Phoenix ICON, 100° FOV. Pediatric retinal photograph (wide-field).
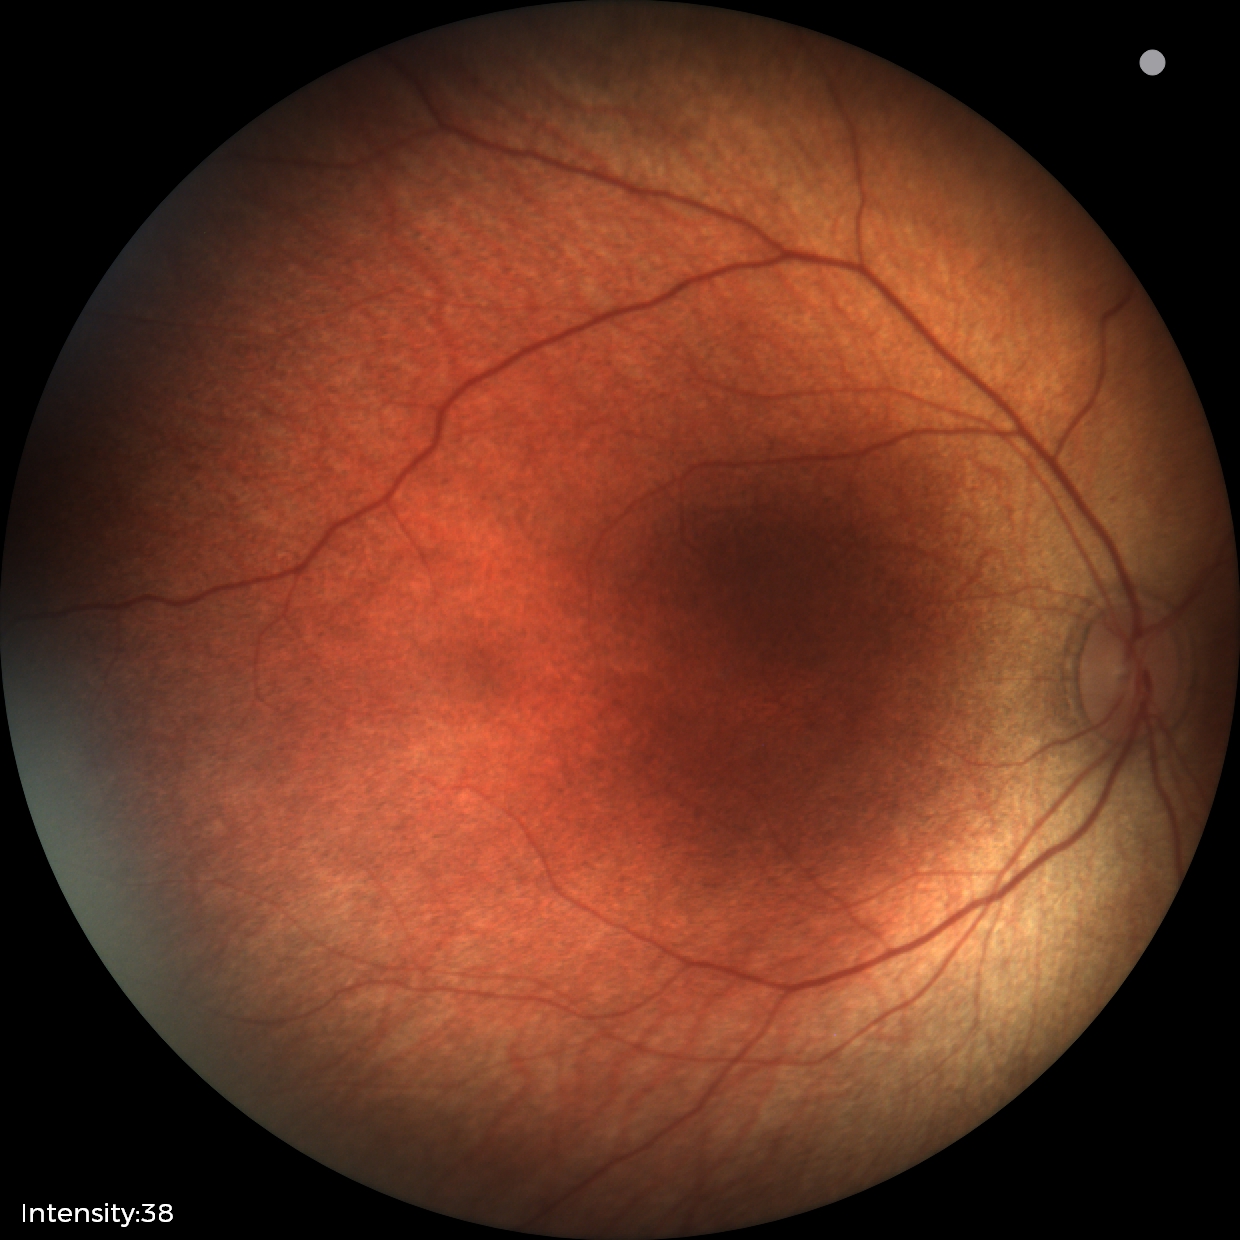

Diagnosis = physiological appearance.